1240x1240; pediatric wide-field fundus photograph
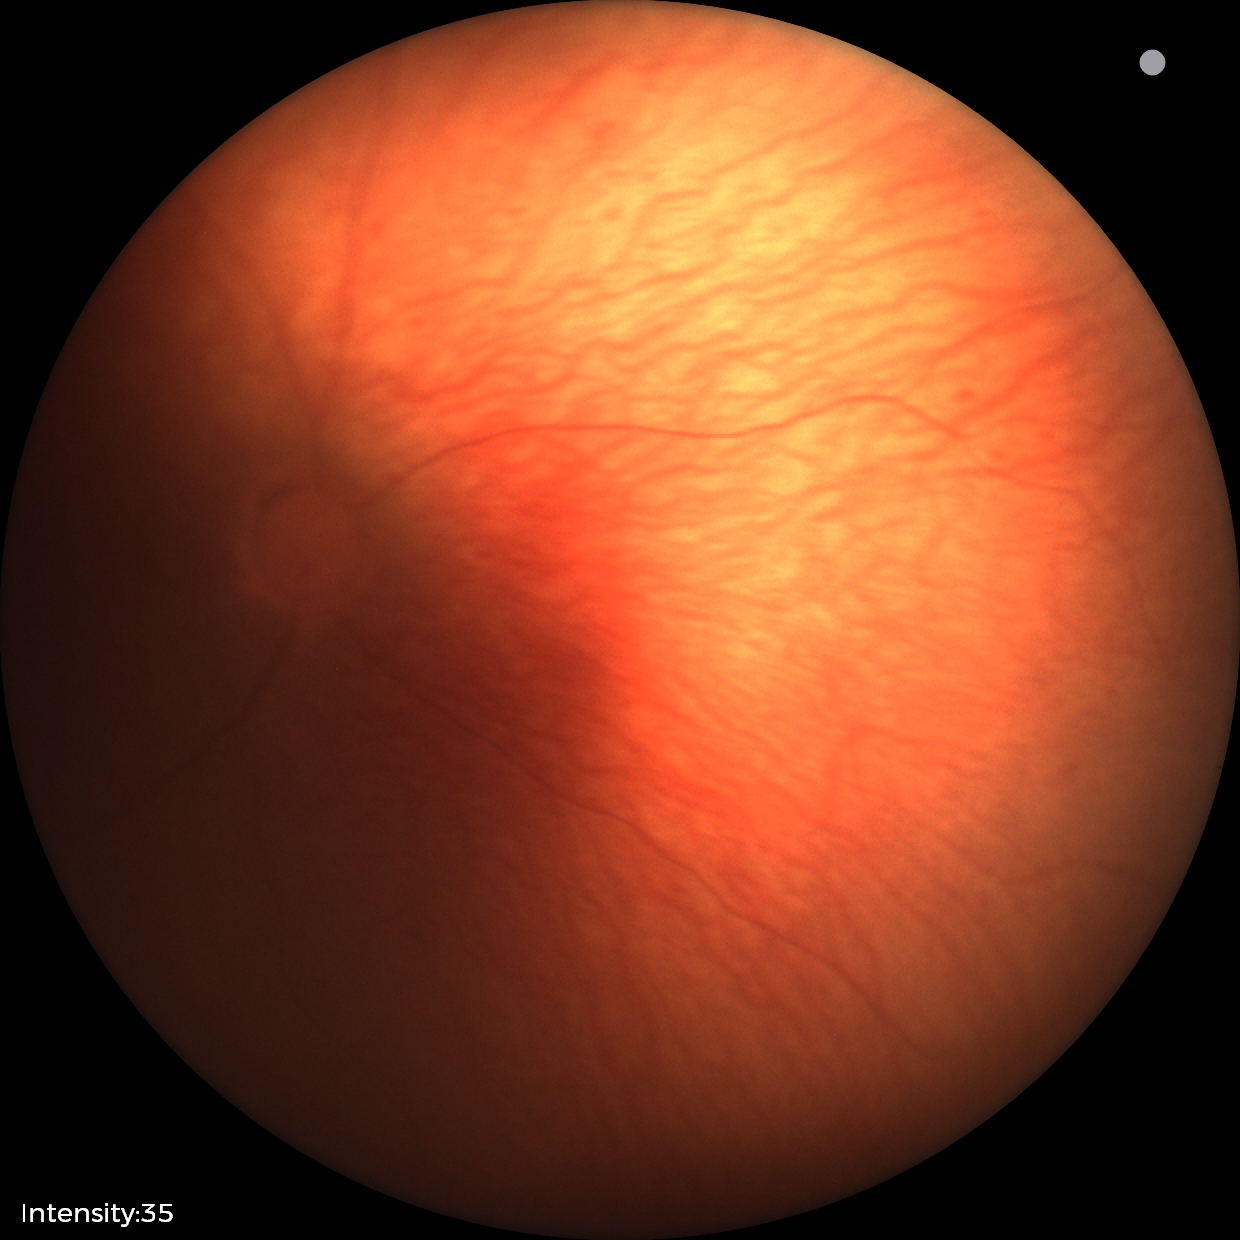 Normal screening examination.